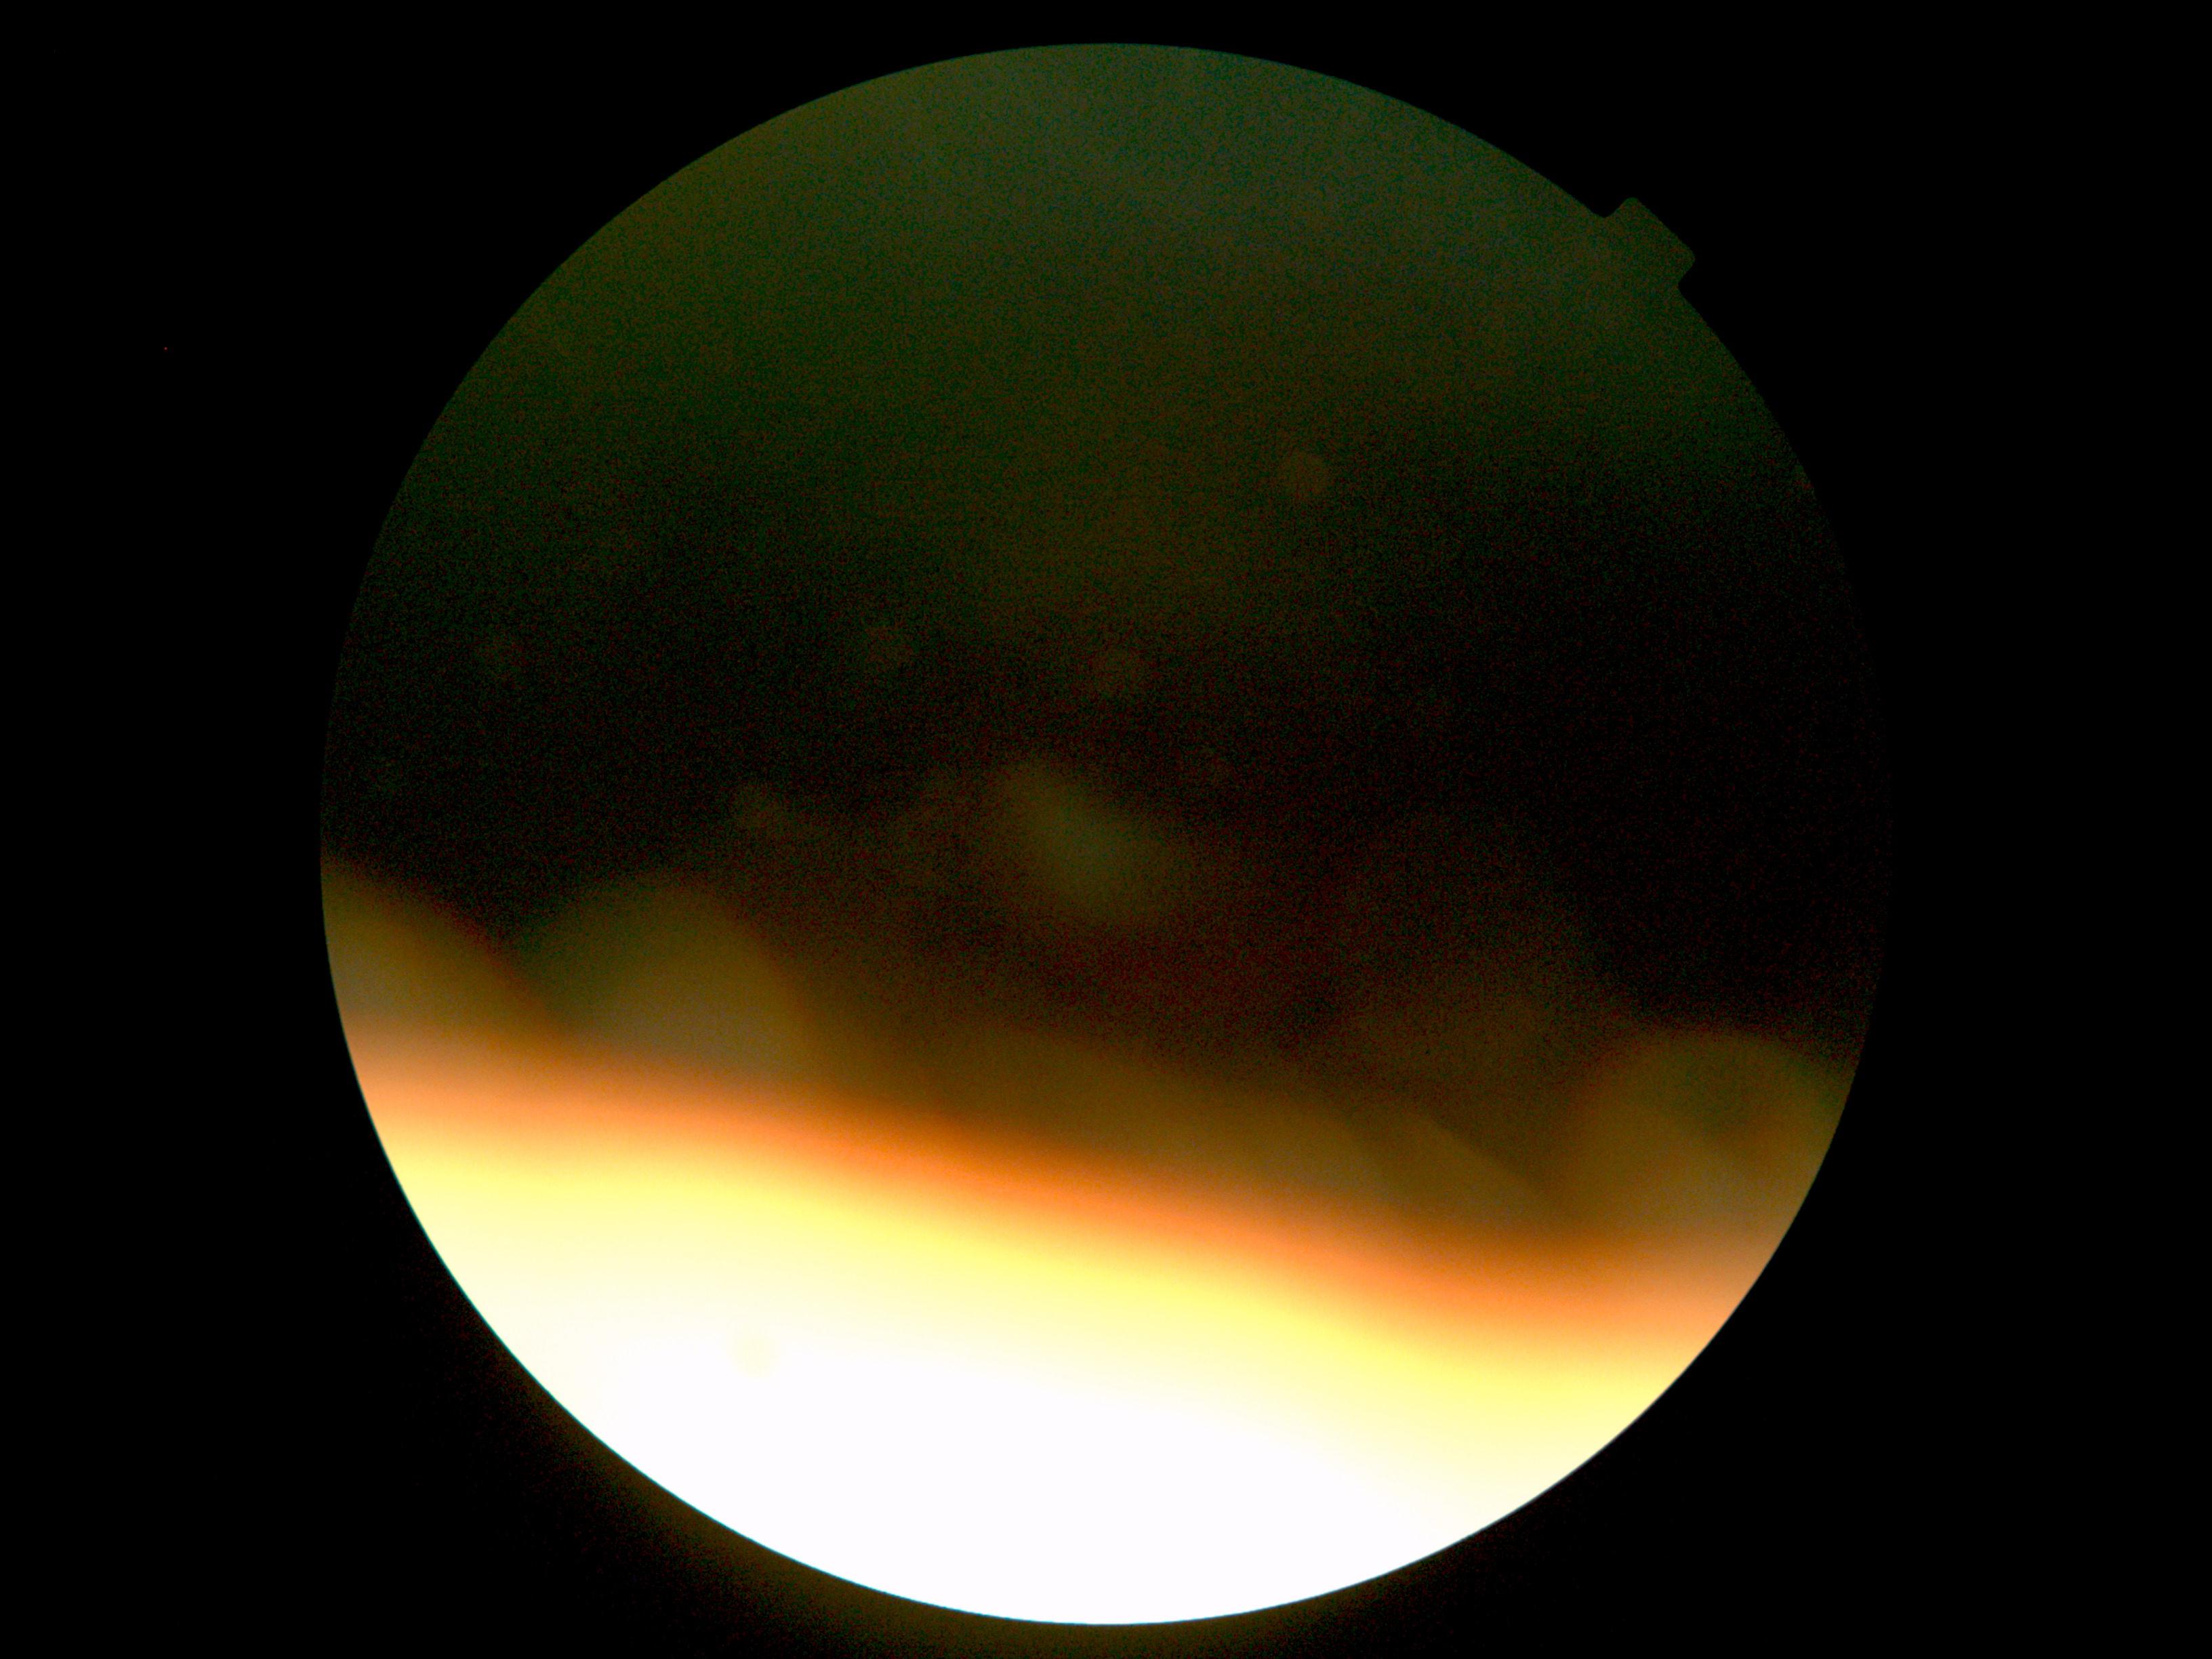
image quality = below grading threshold; DR = ungradable.